FOV: 45 degrees.
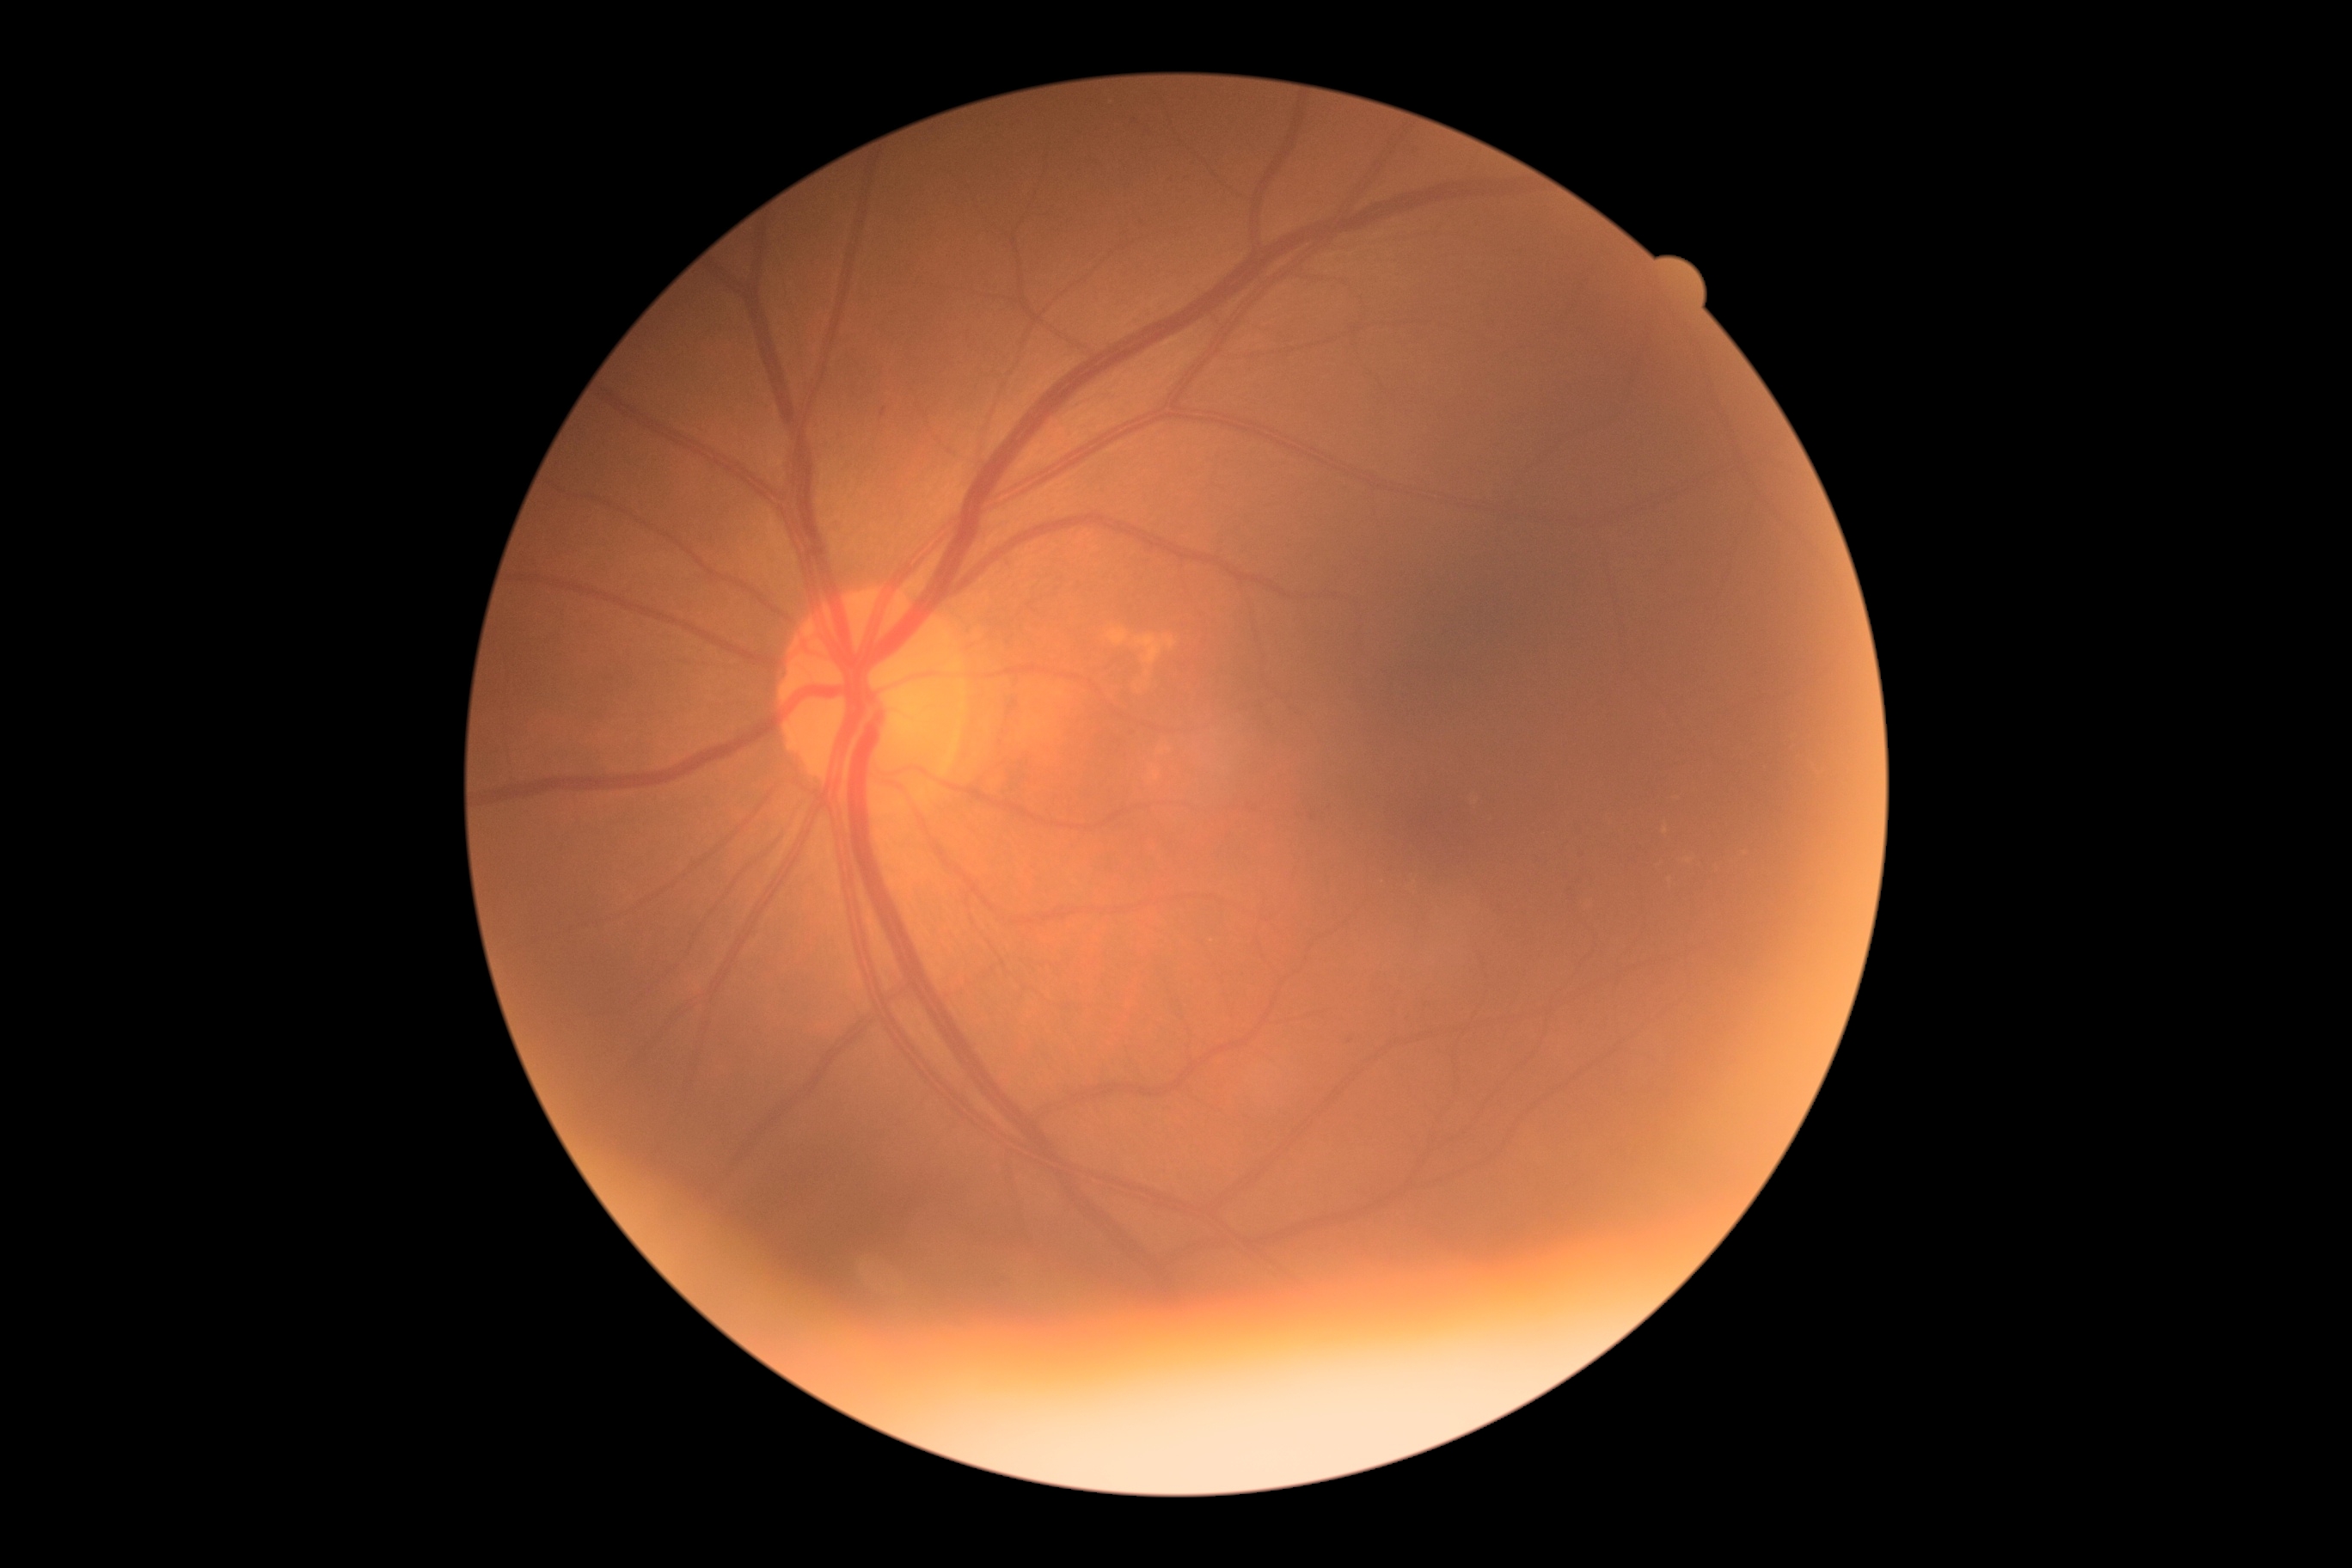
Annotations:
* retinopathy: mild NPDR (grade 1)
* DR class: non-proliferative diabetic retinopathy